Captured with the Natus RetCam Envision (130° field of view); wide-field fundus photograph of an infant — 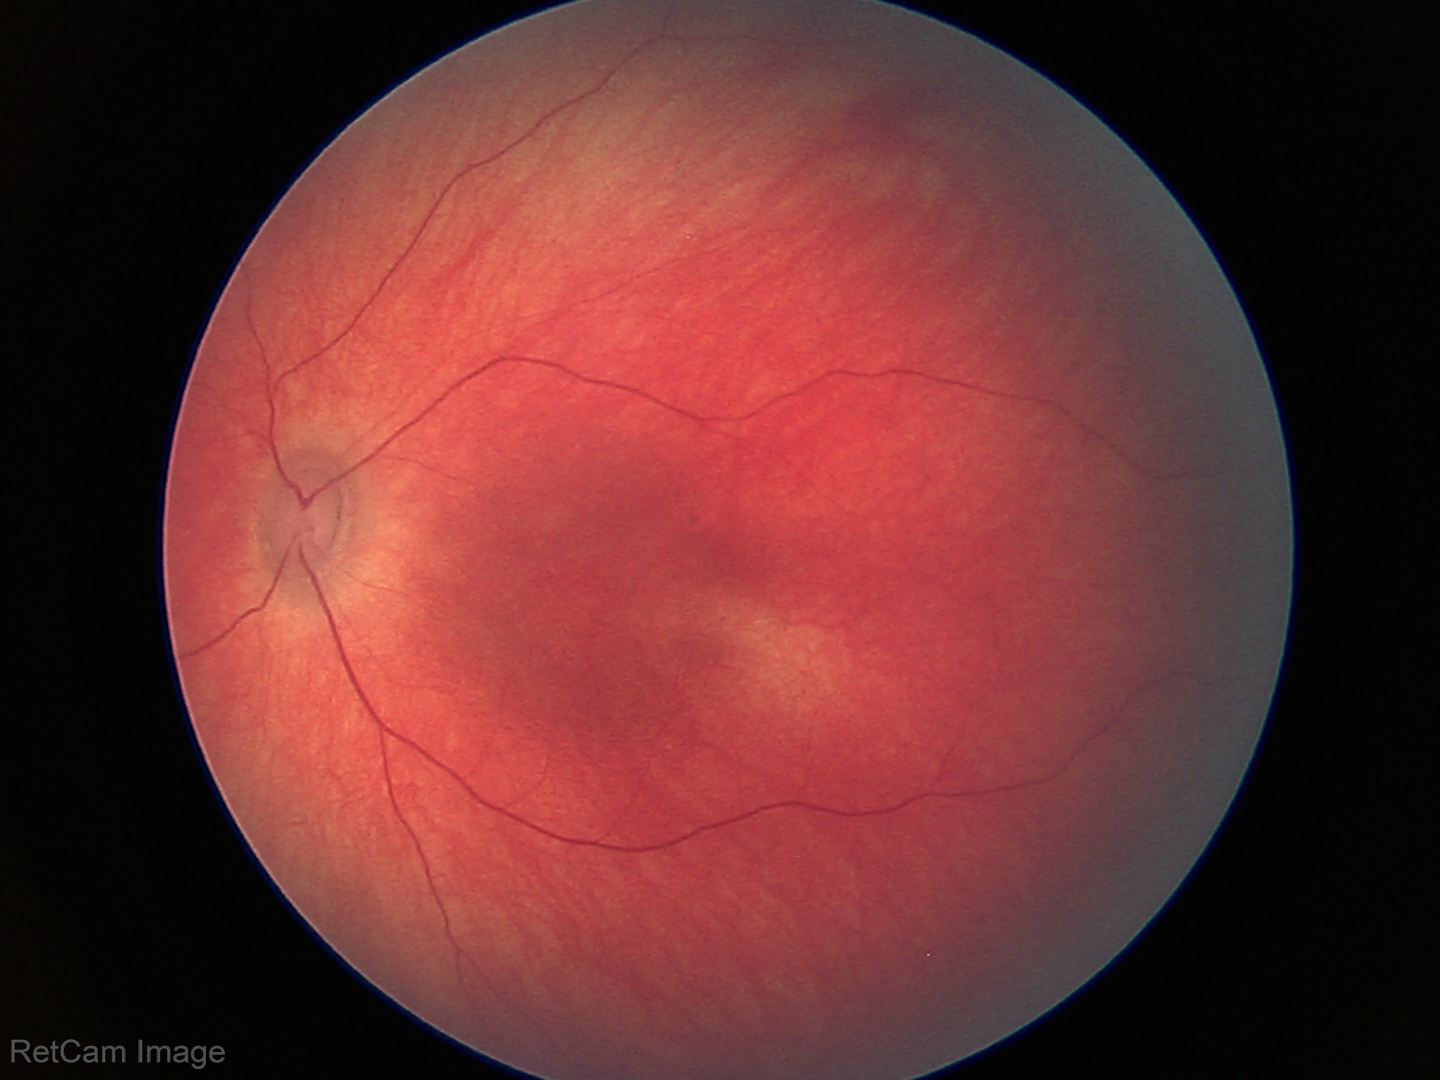
Q: What is the screening diagnosis?
A: physiological finding